1504x1000px:
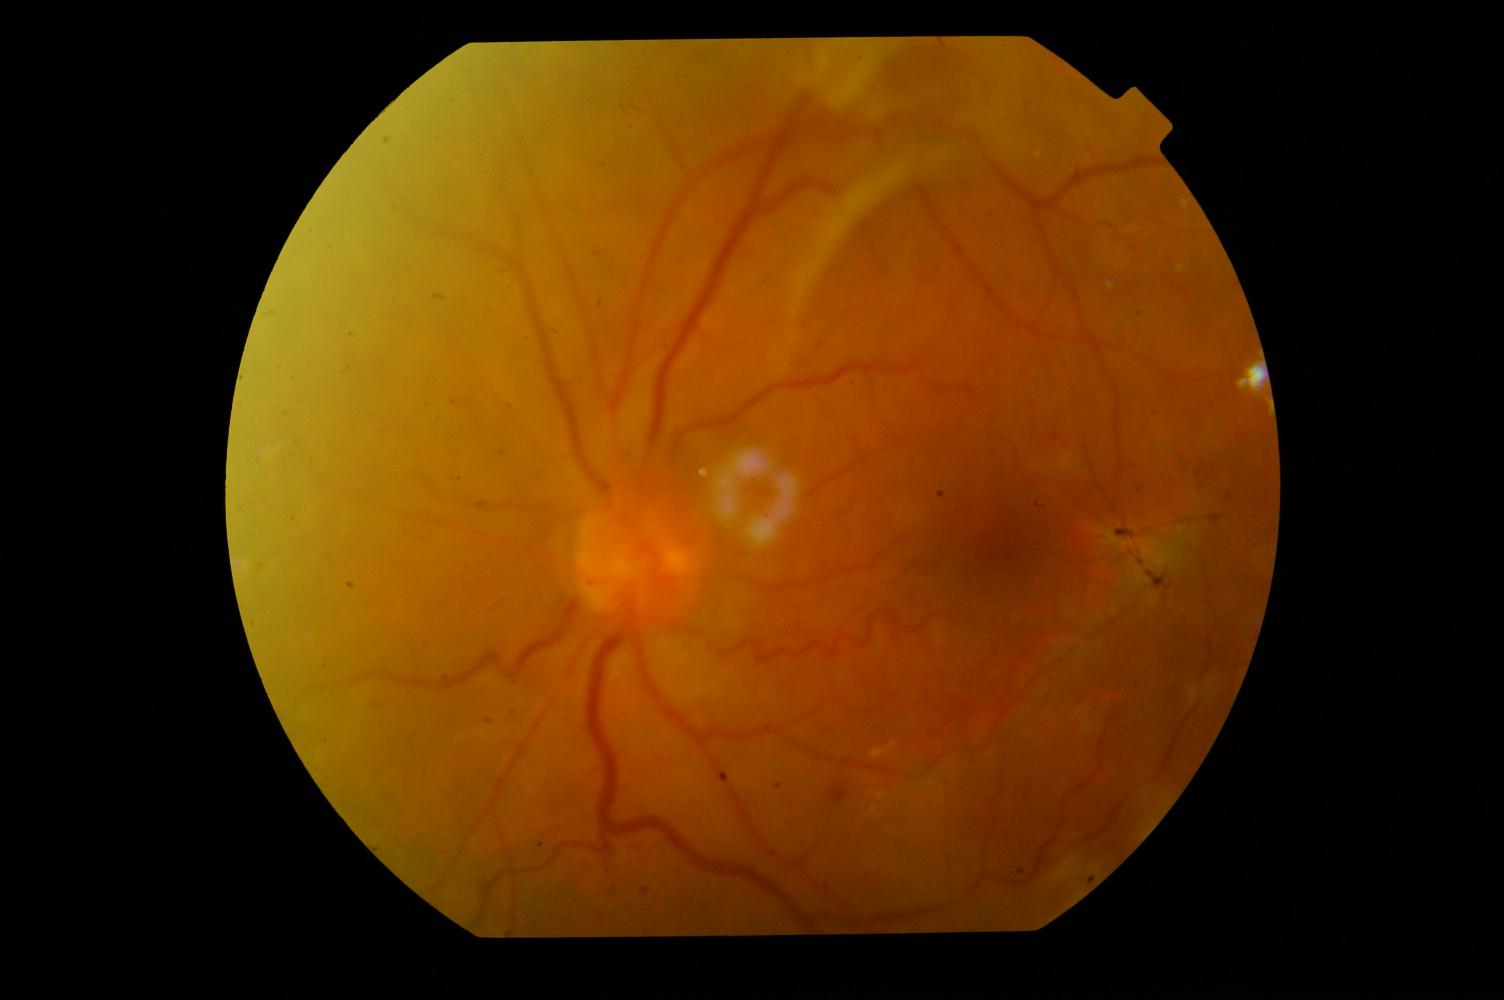
Fundus appearance consistent with diabetic retinopathy (DR).